Retinal fundus photograph
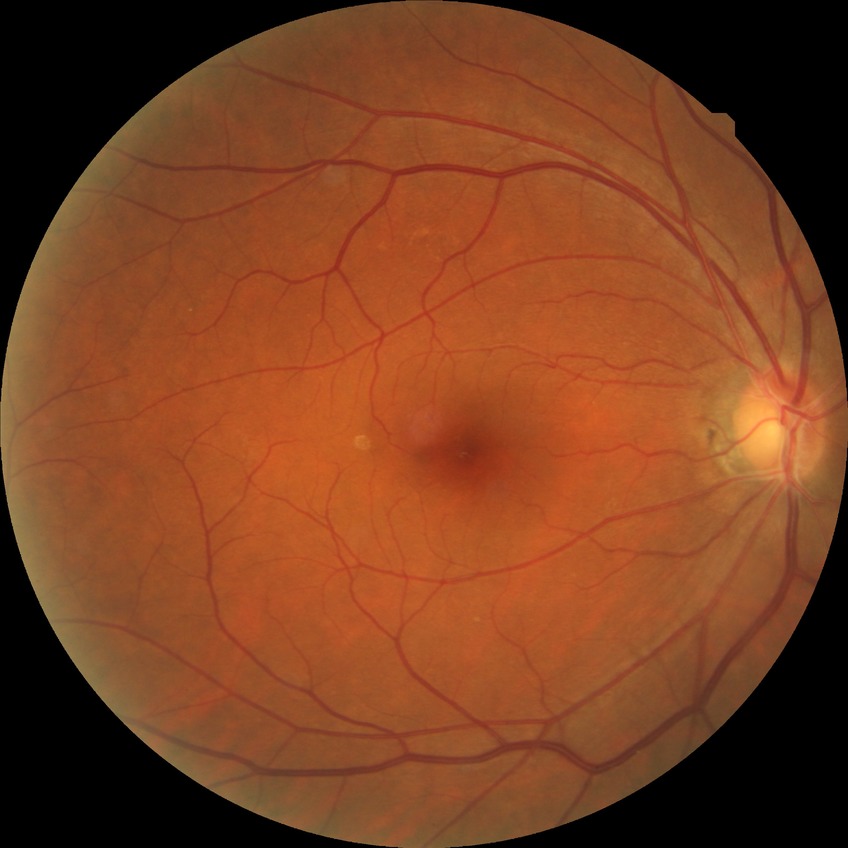
Diabetic retinopathy severity: no diabetic retinopathy.